Color fundus image, acquired with a NIDEK AFC-230, FOV: 45 degrees, without pupil dilation, 848x848 — 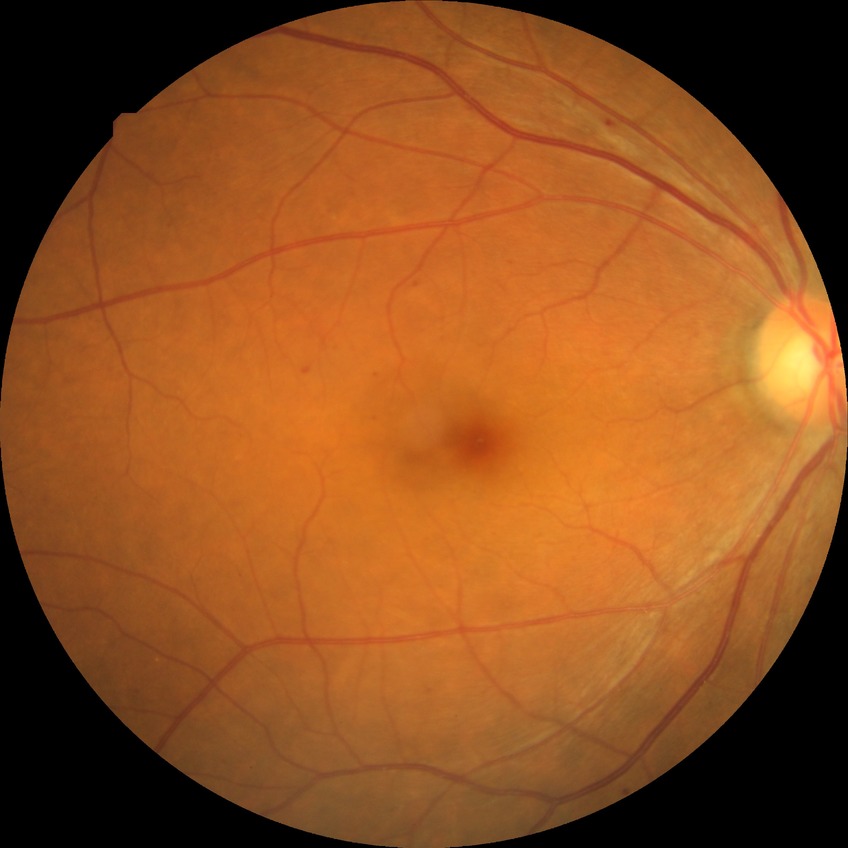

Diabetic retinopathy stage: simple diabetic retinopathy.